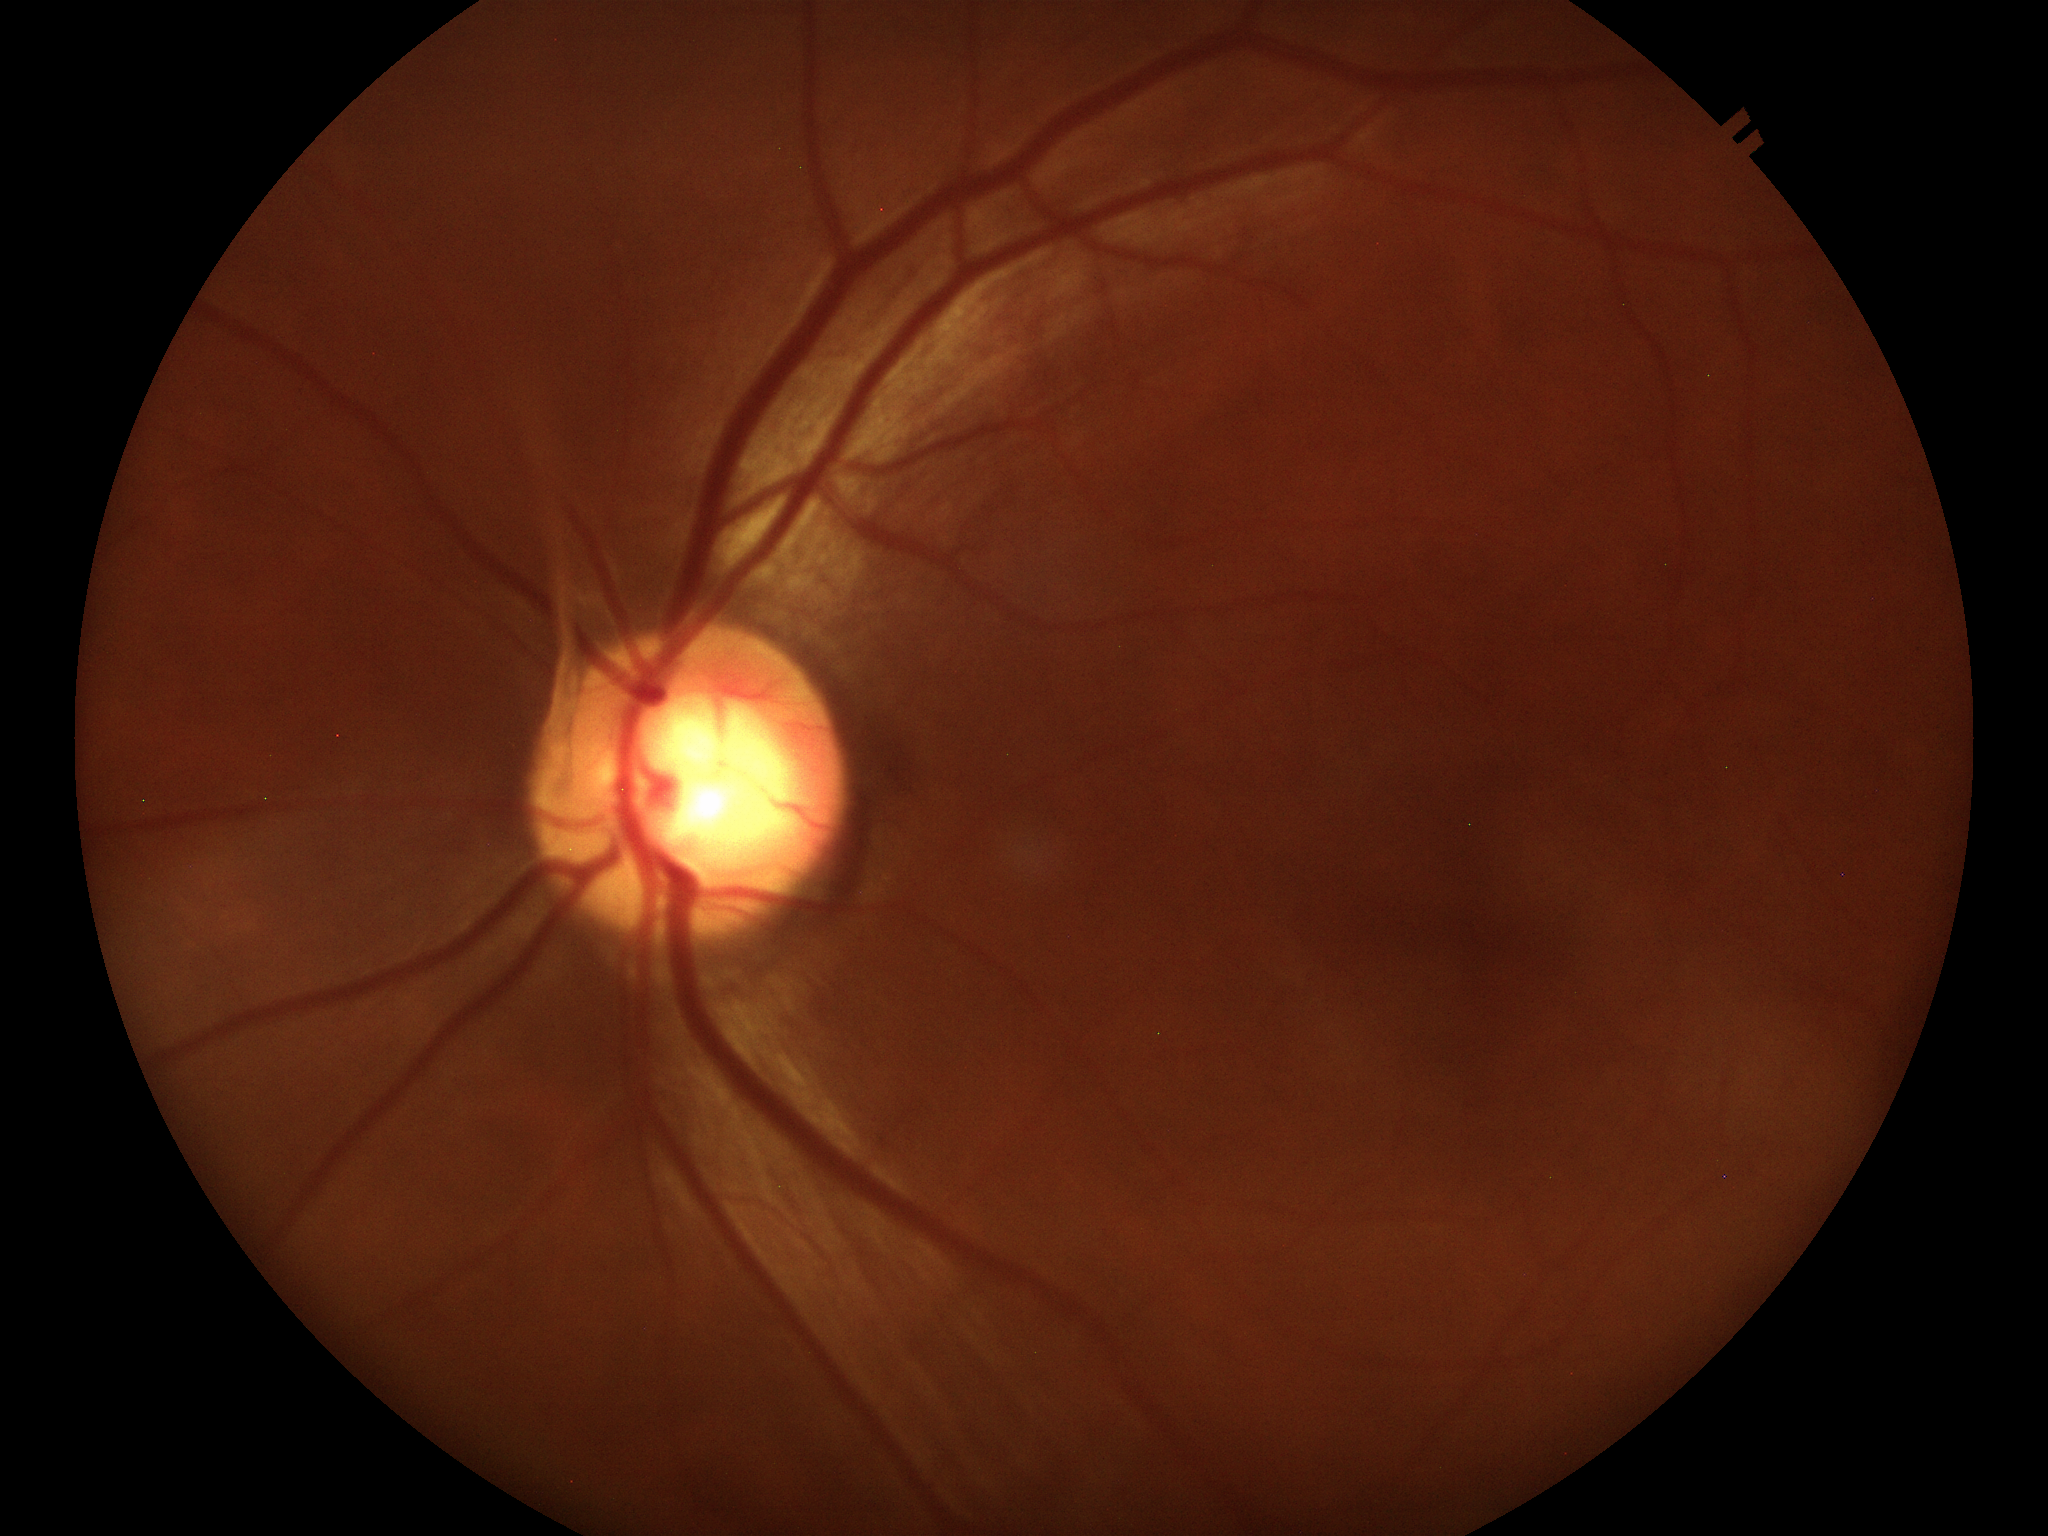 glaucoma_decision: suspicious (unanimous glaucoma-suspect call)
vcdr: 0.64